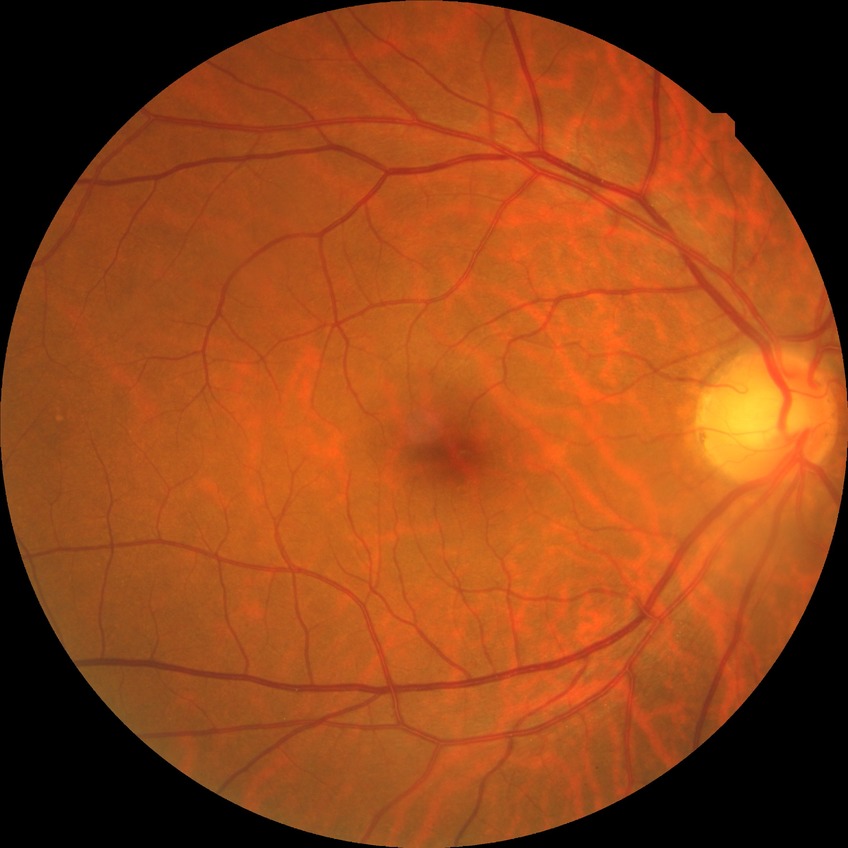 Retinopathy grade: no diabetic retinopathy.